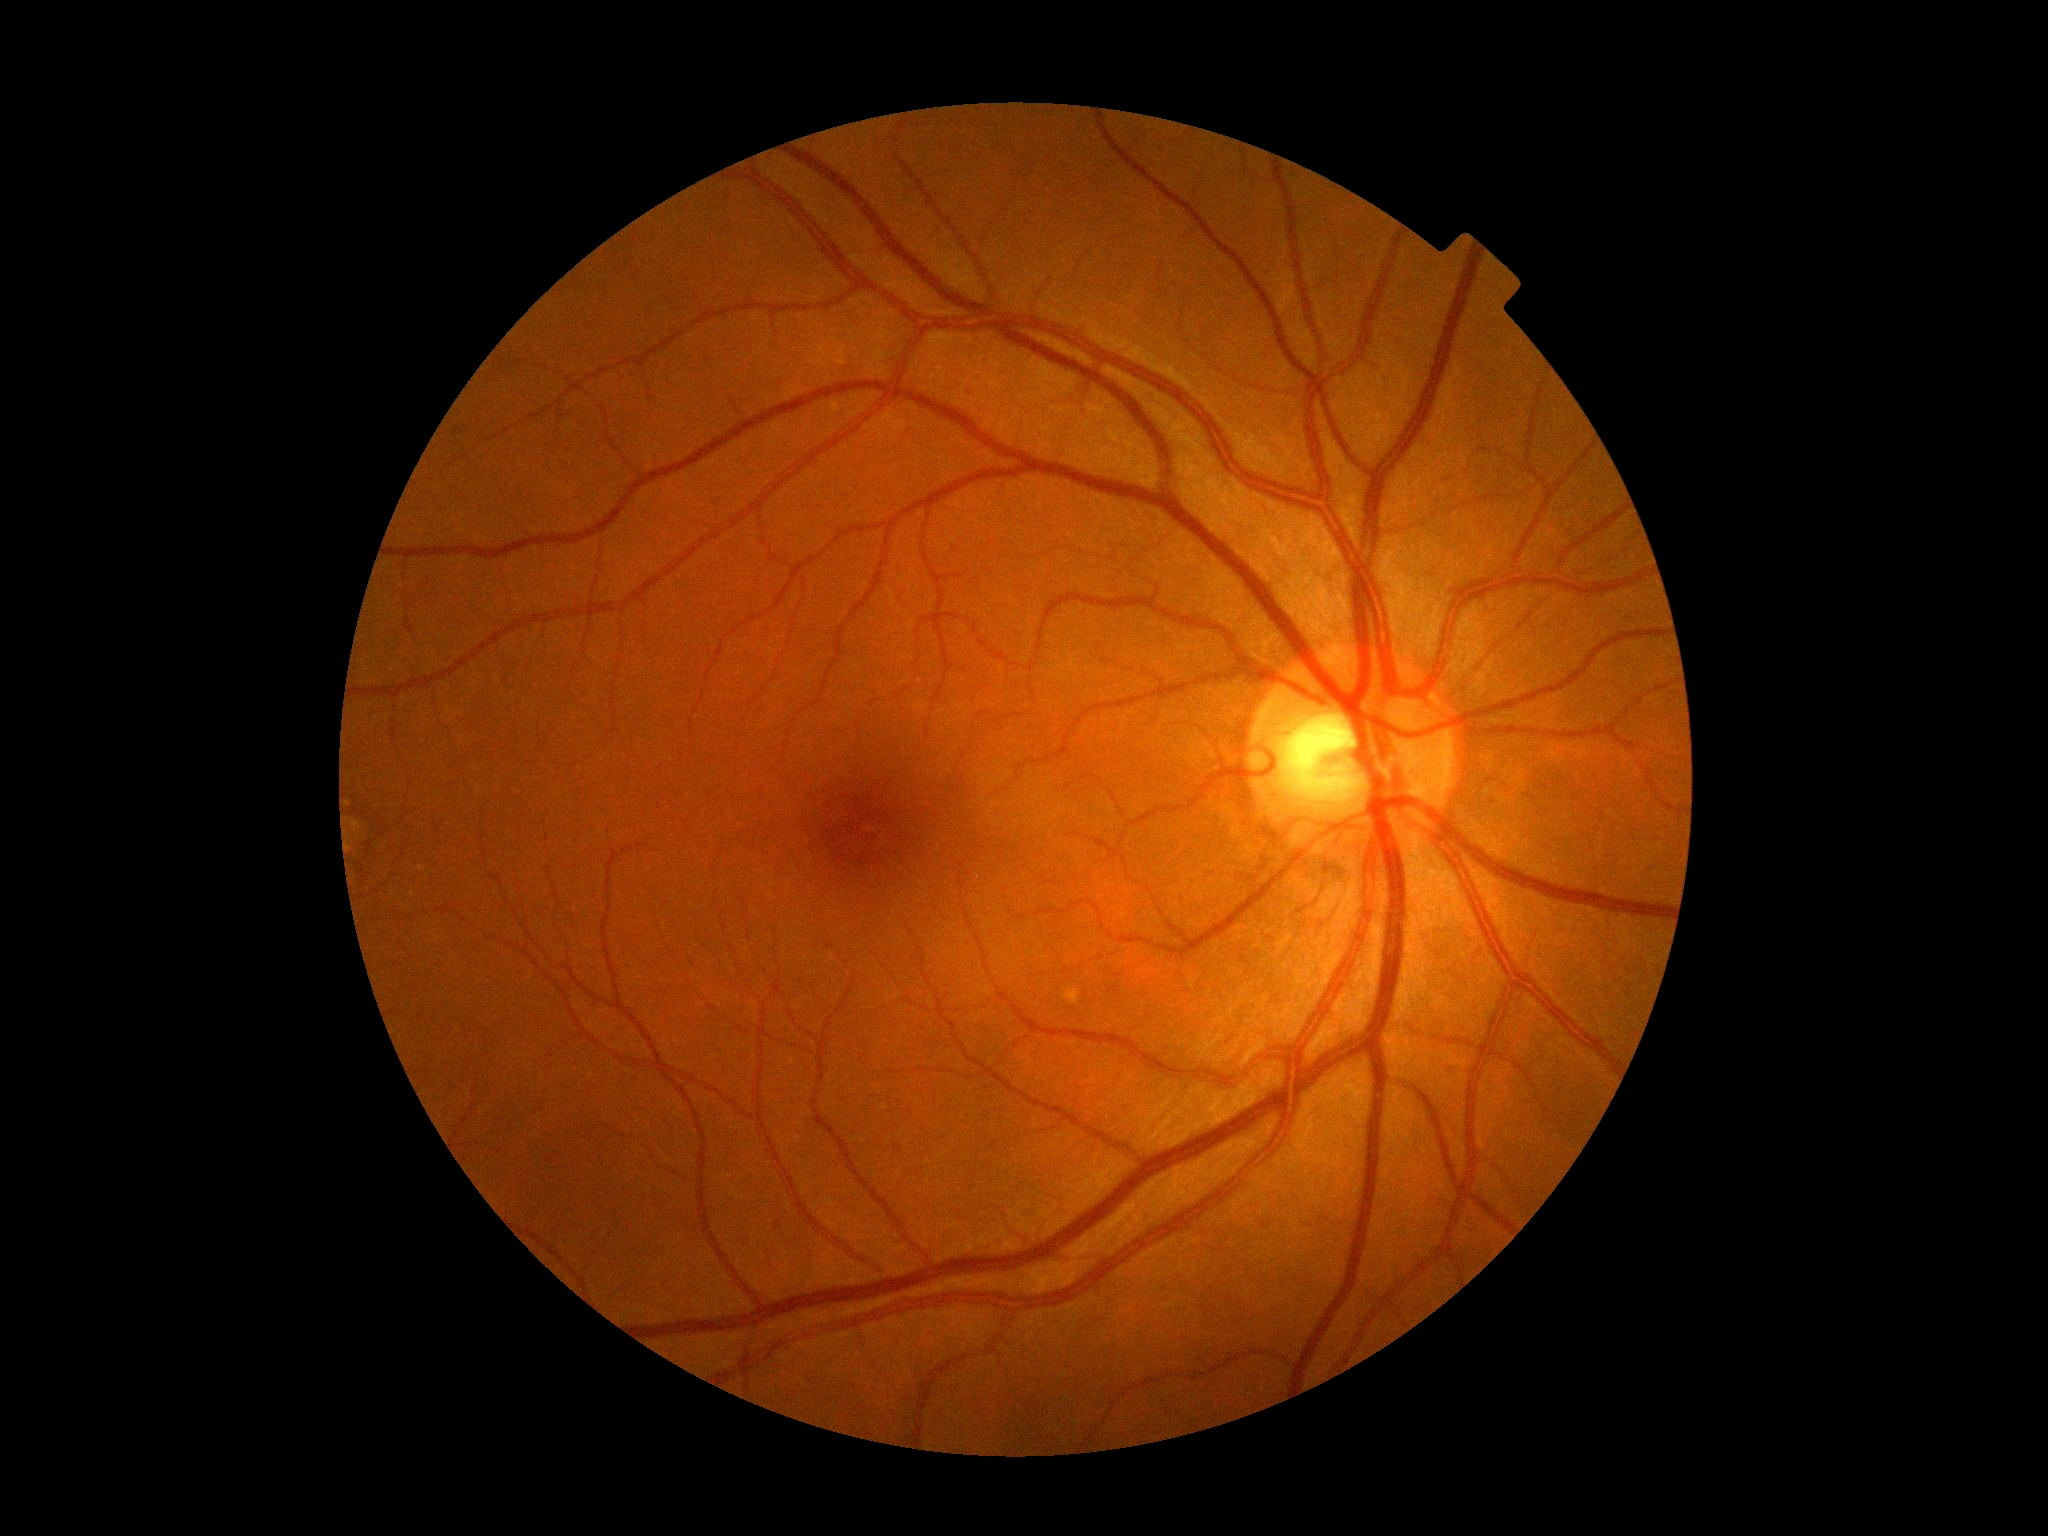 {"dr_grade": "grade 0"}